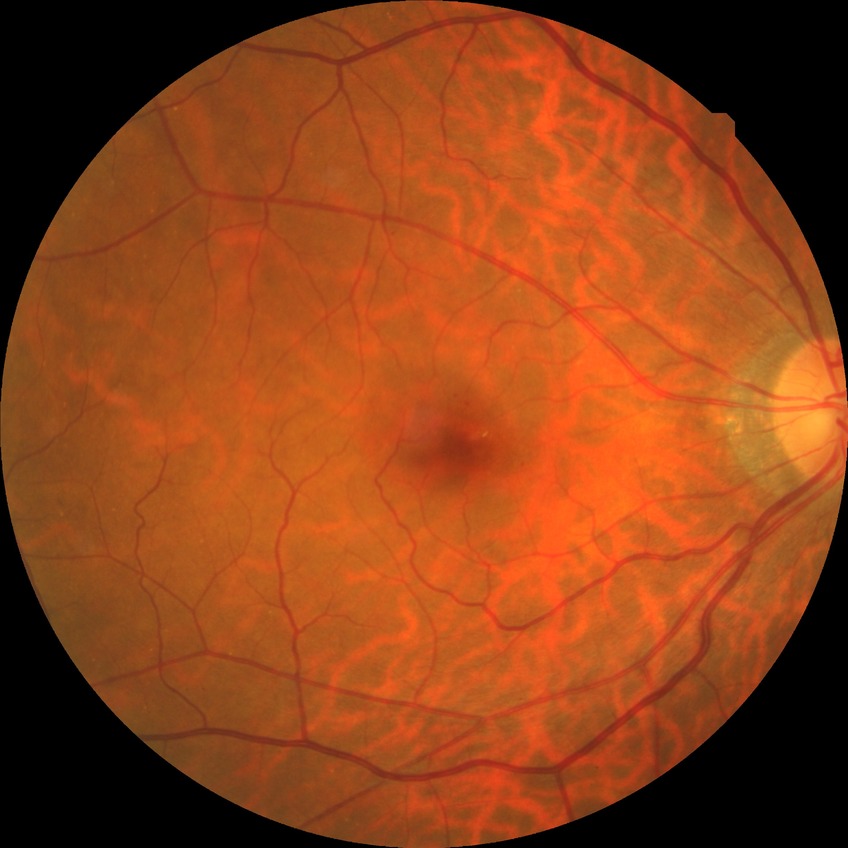
DR class = non-proliferative diabetic retinopathy; diabetic retinopathy (DR) = simple diabetic retinopathy (SDR).